Fundus photo · FOV: 45 degrees
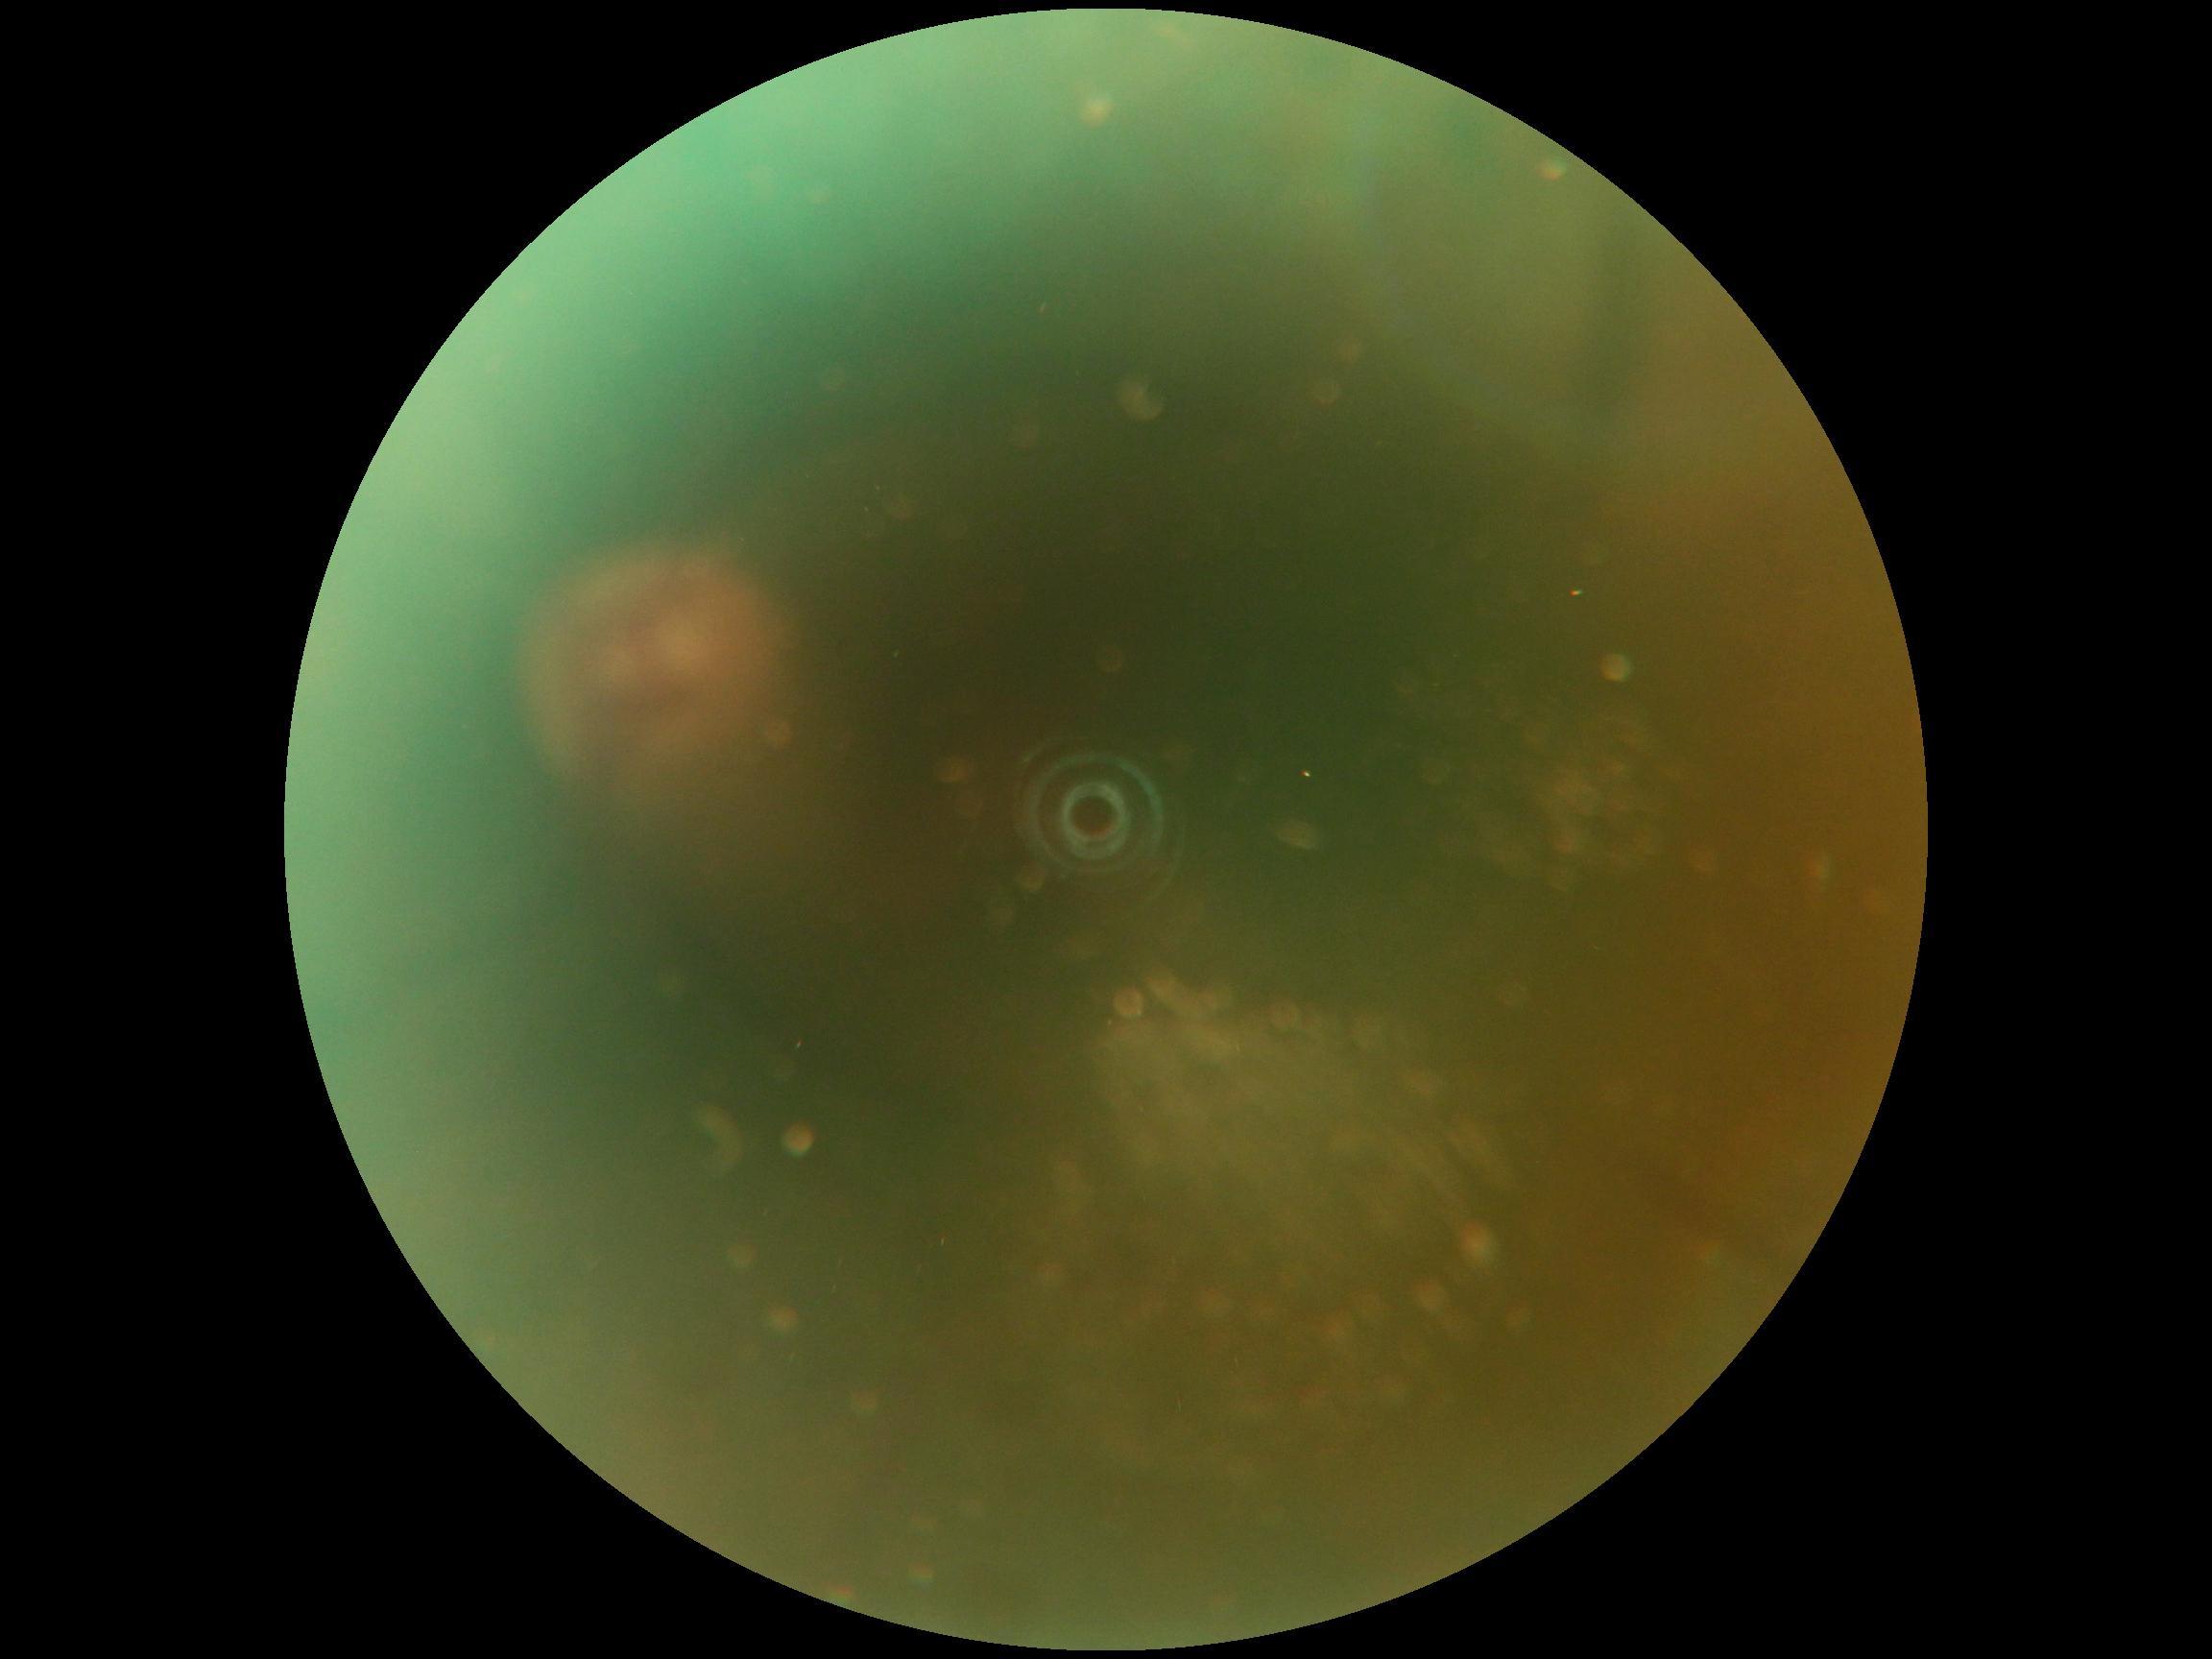

Quality too poor to assess for DR. DR severity is ungradable.